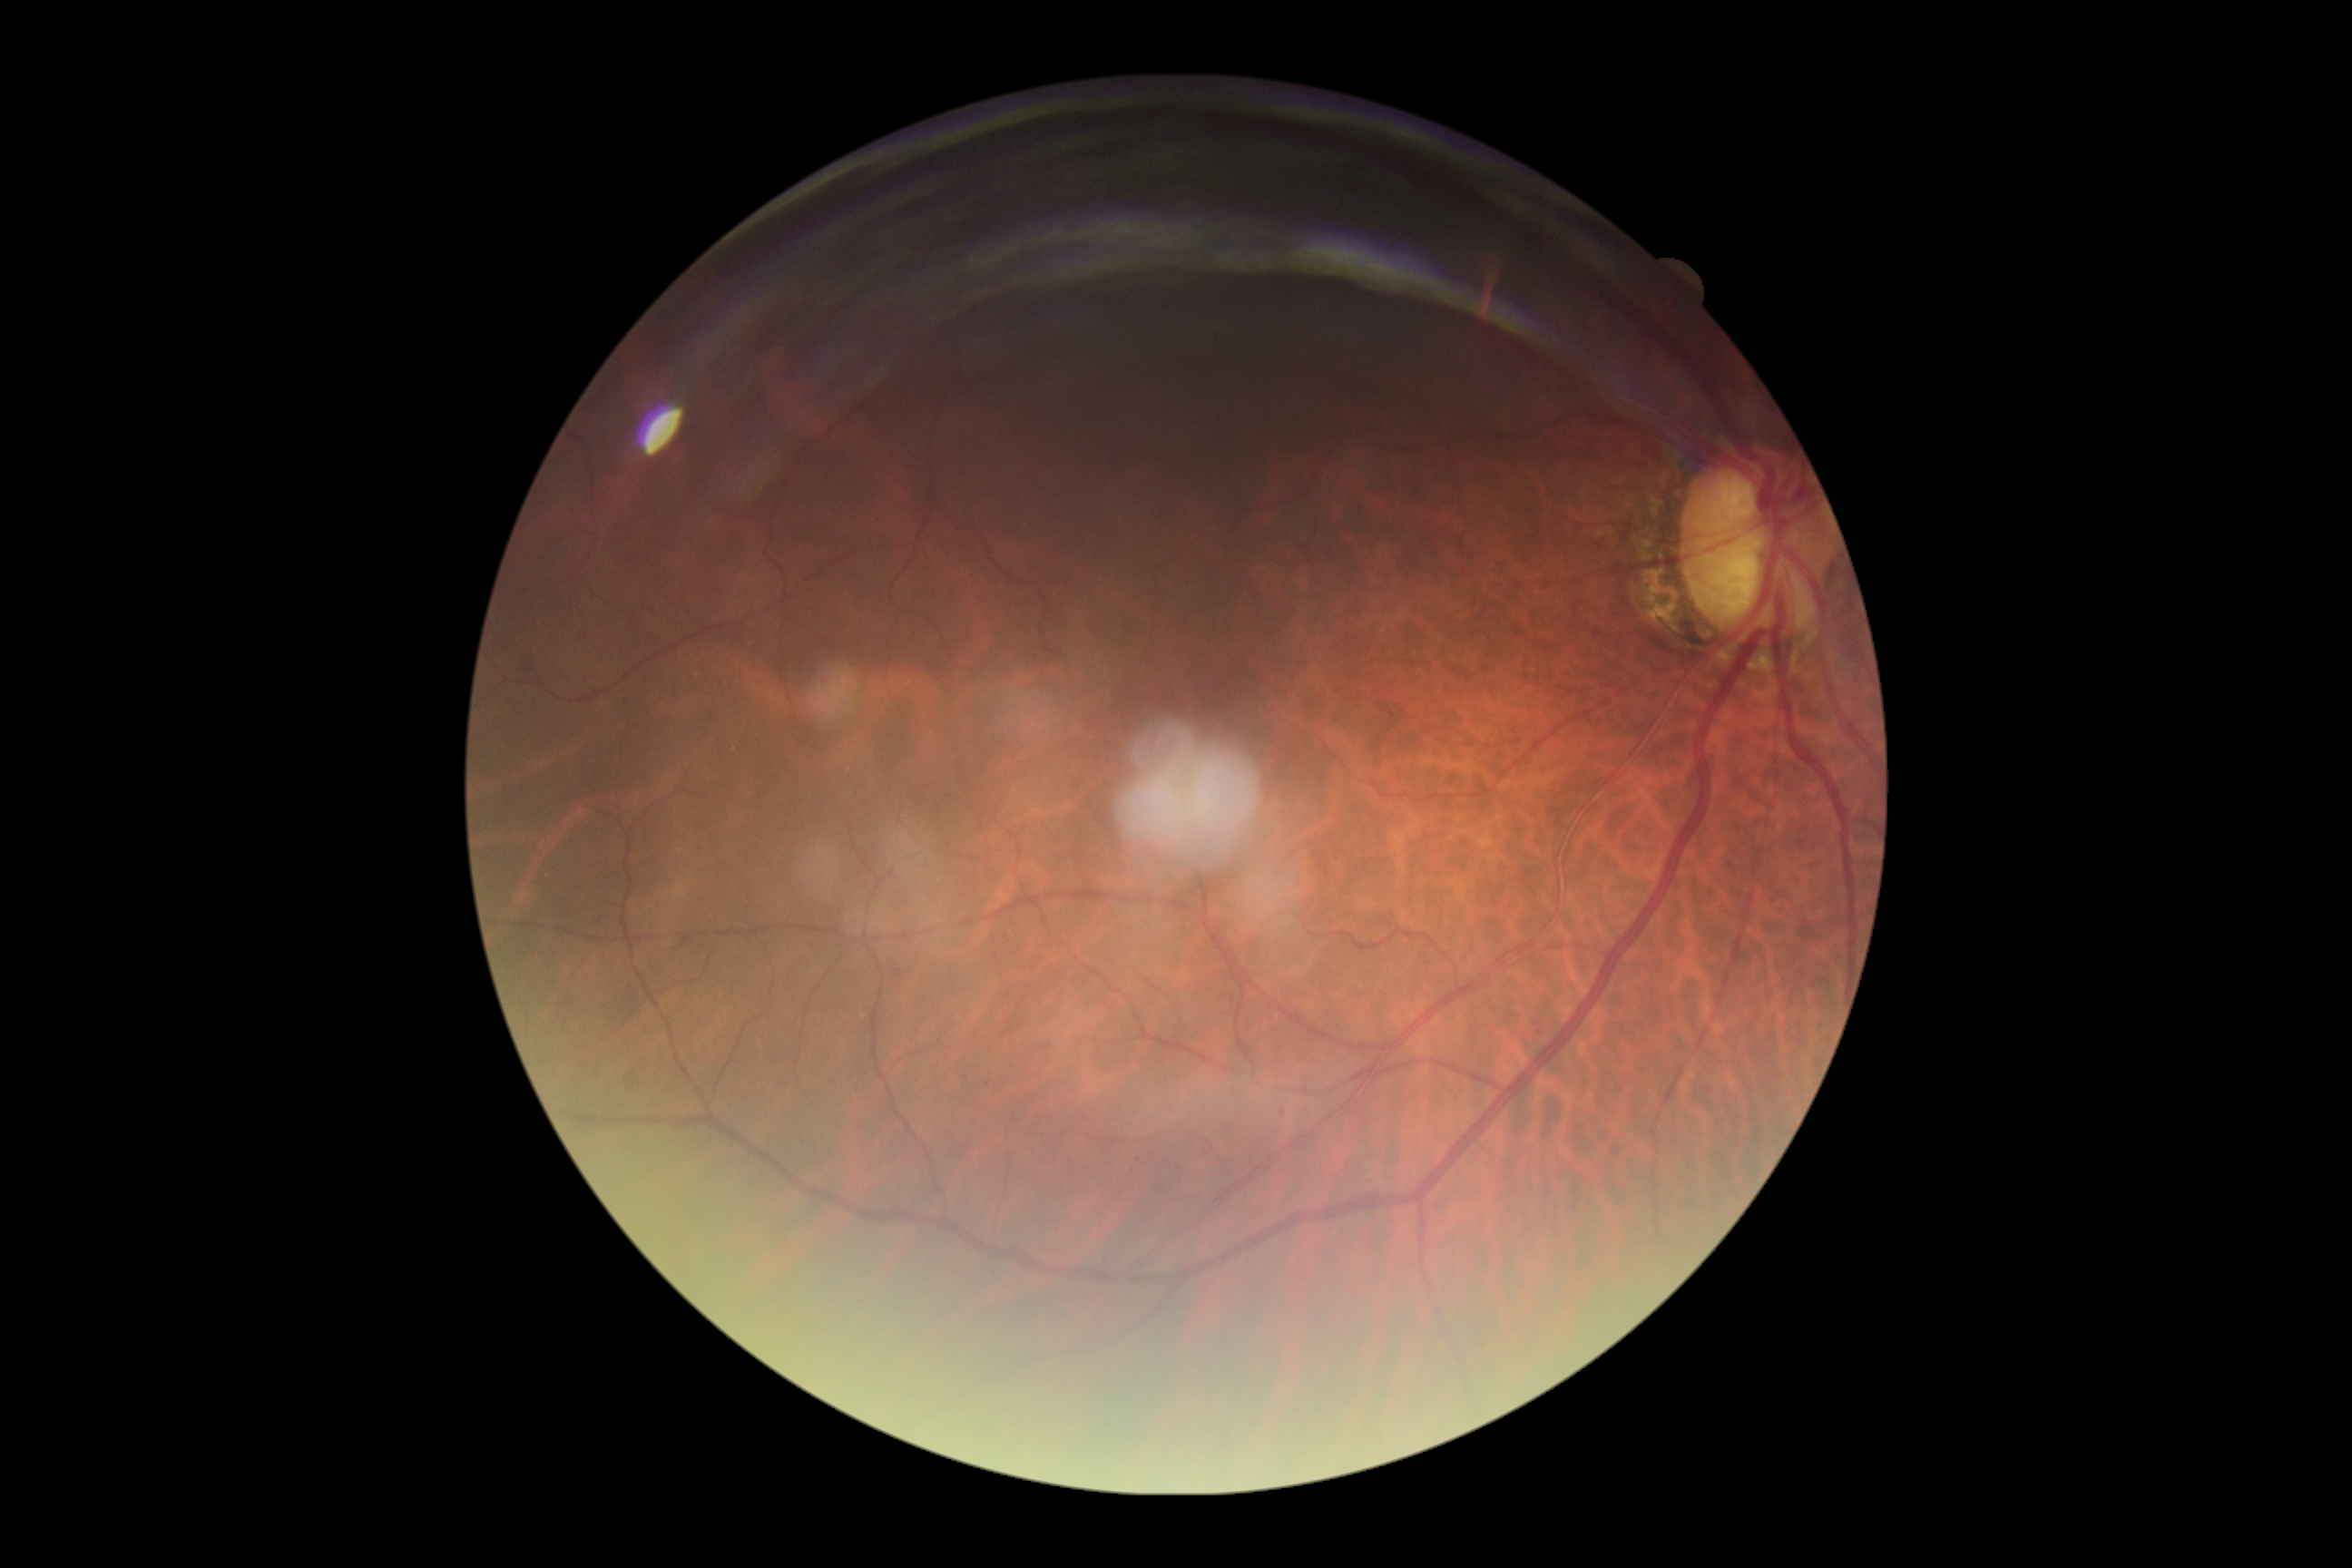 DR grade is 1/4.